Without pupil dilation. Modified Davis classification. 848 by 848 pixels. NIDEK AFC-230. Posterior pole color fundus photograph: 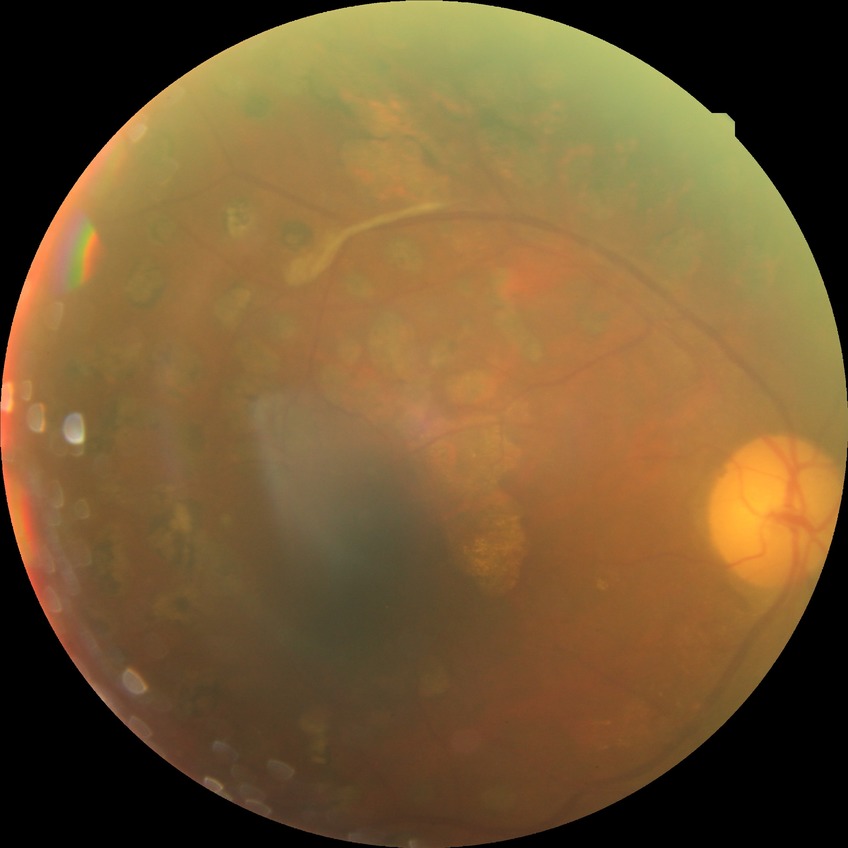 Diabetic retinopathy (DR): PDR (proliferative diabetic retinopathy).